Fundus photo
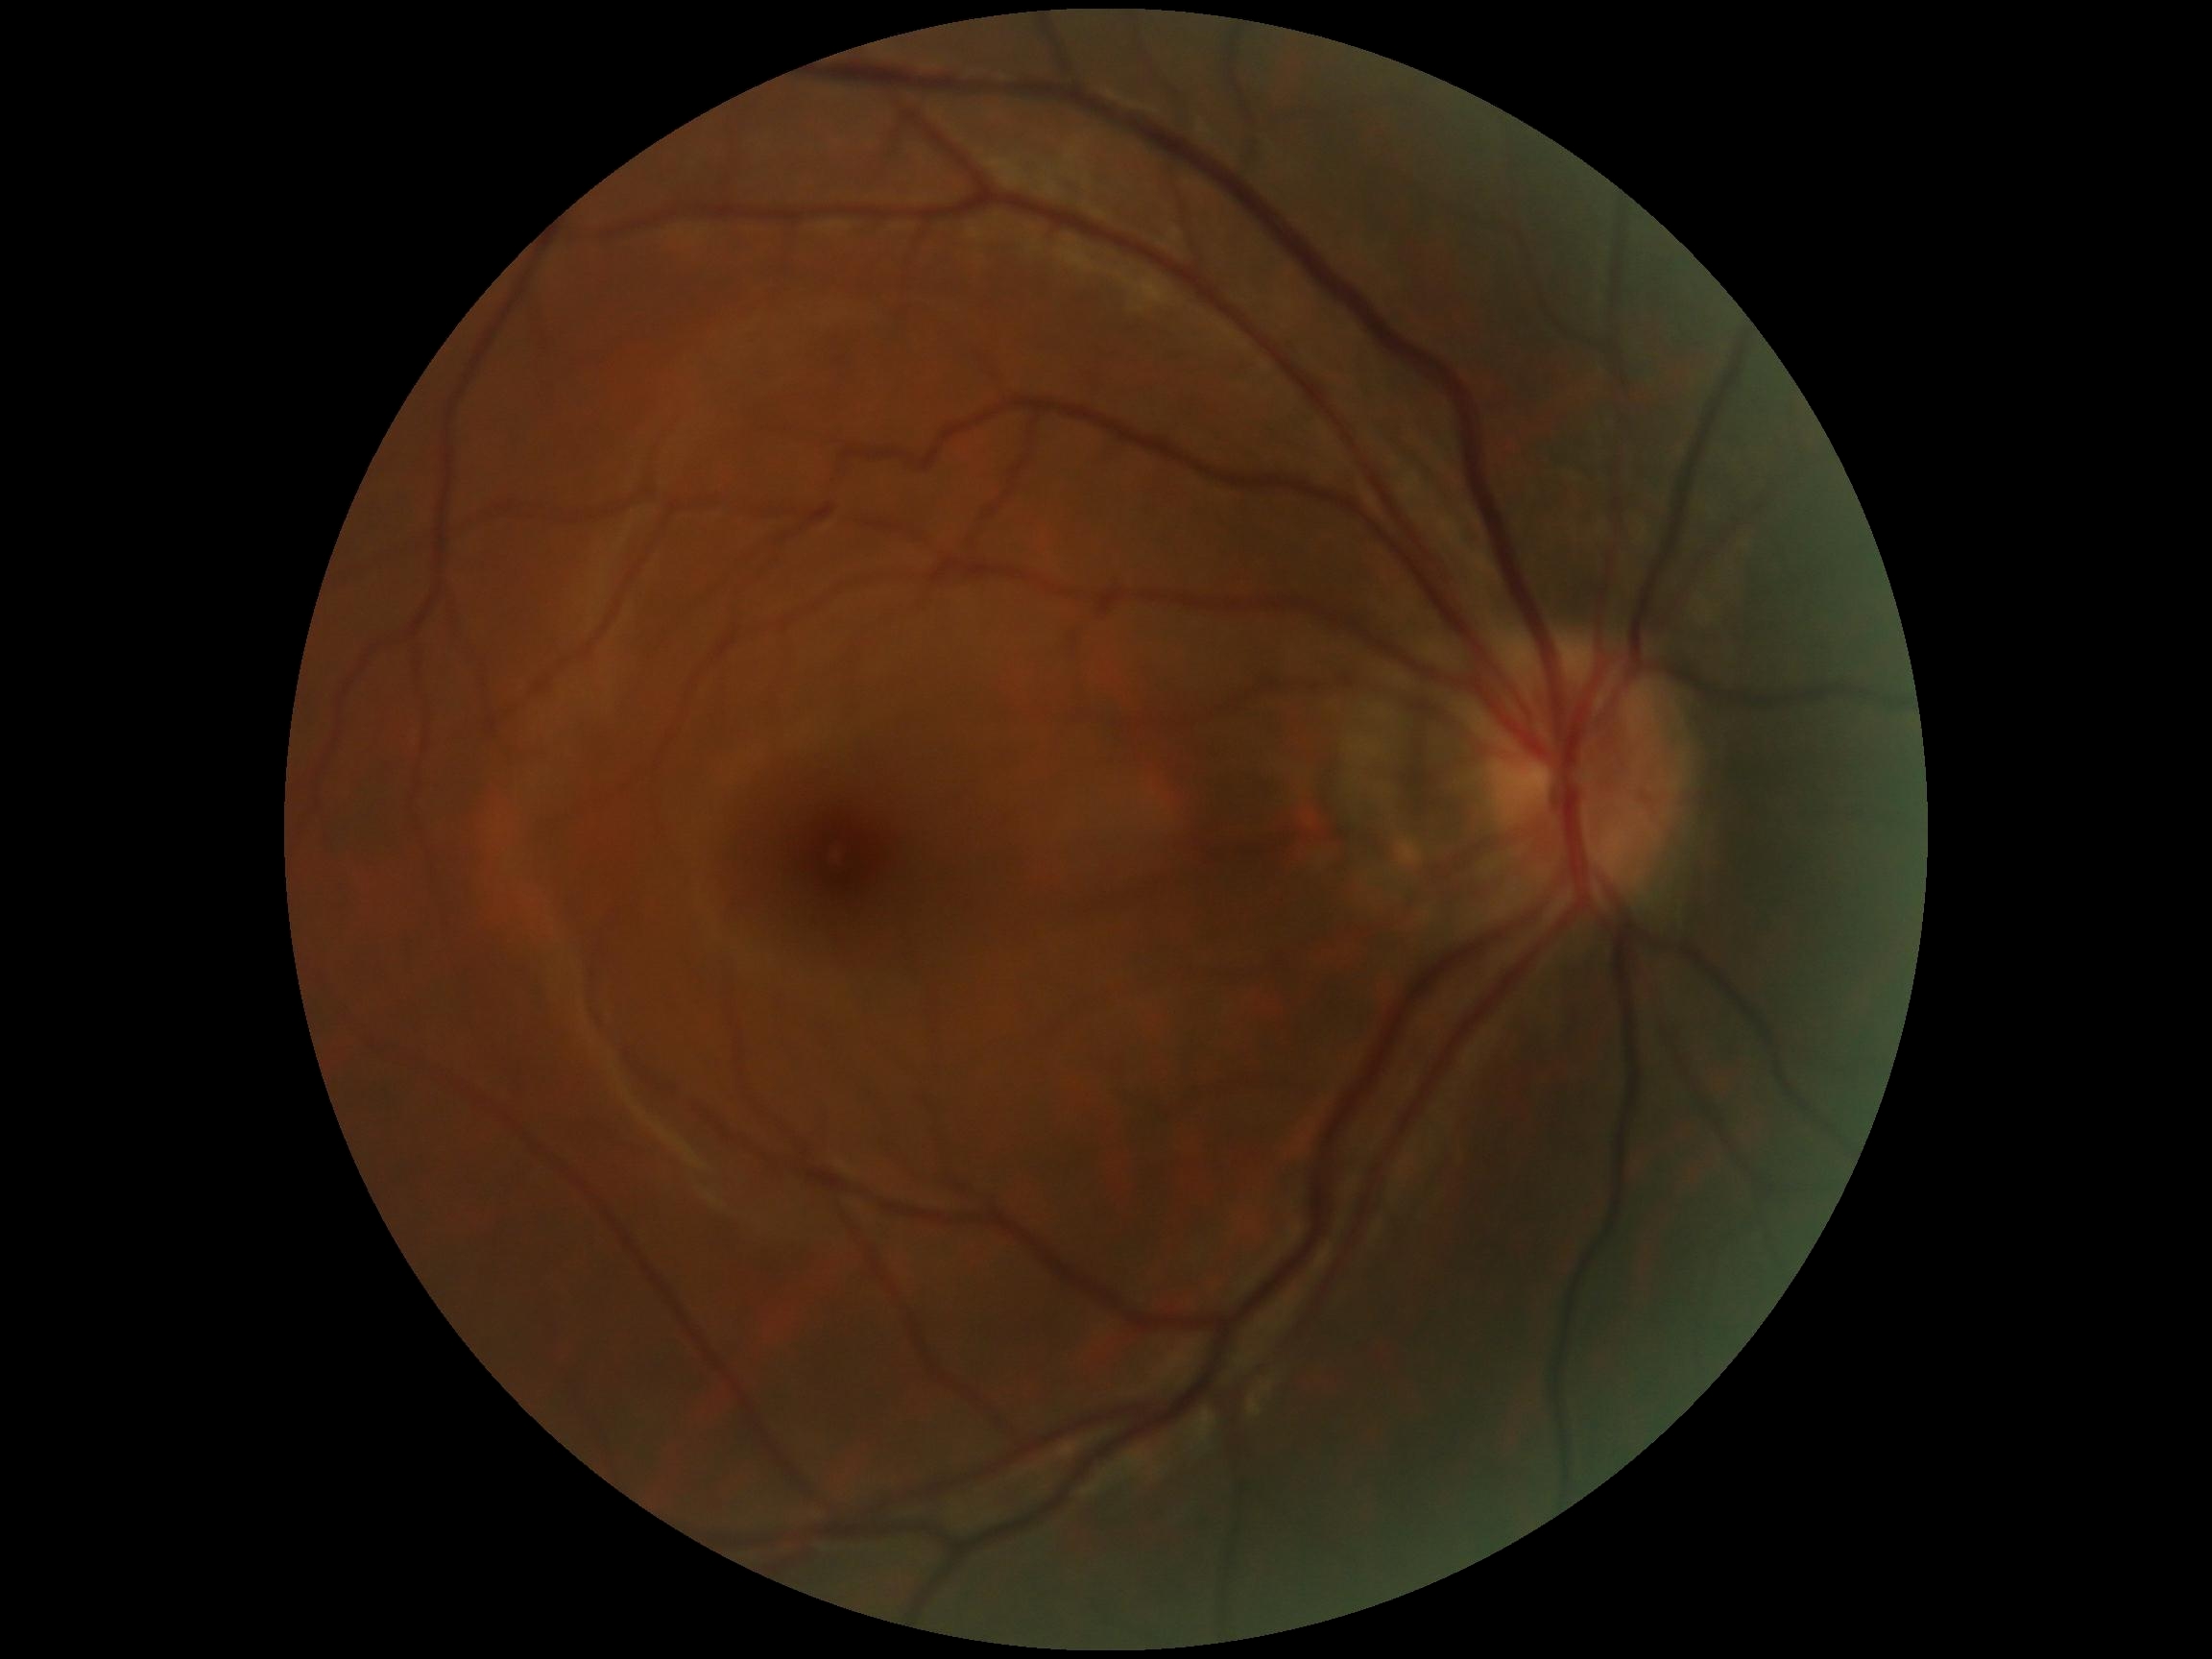 DR: 0 — no visible signs of diabetic retinopathy.